Camera: Natus RetCam Envision (130° FOV). Image size 1440x1080. Infant wide-field retinal image — 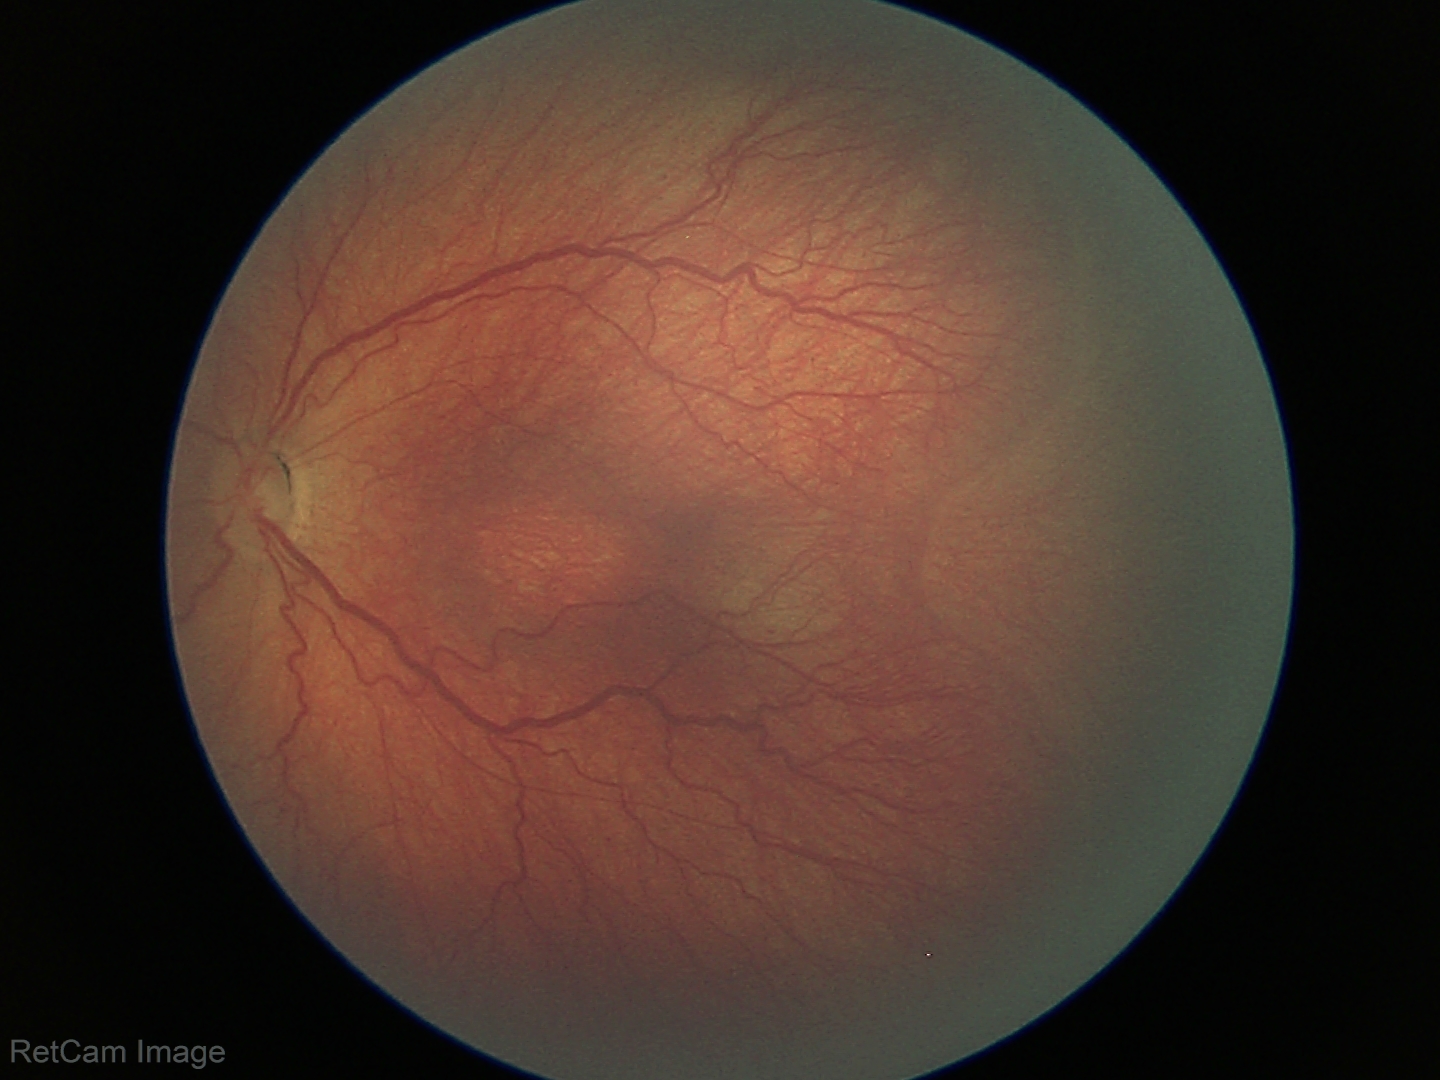
Diagnosis from this screening exam: retinopathy of prematurity (ROP) stage 3. Plus disease absent.